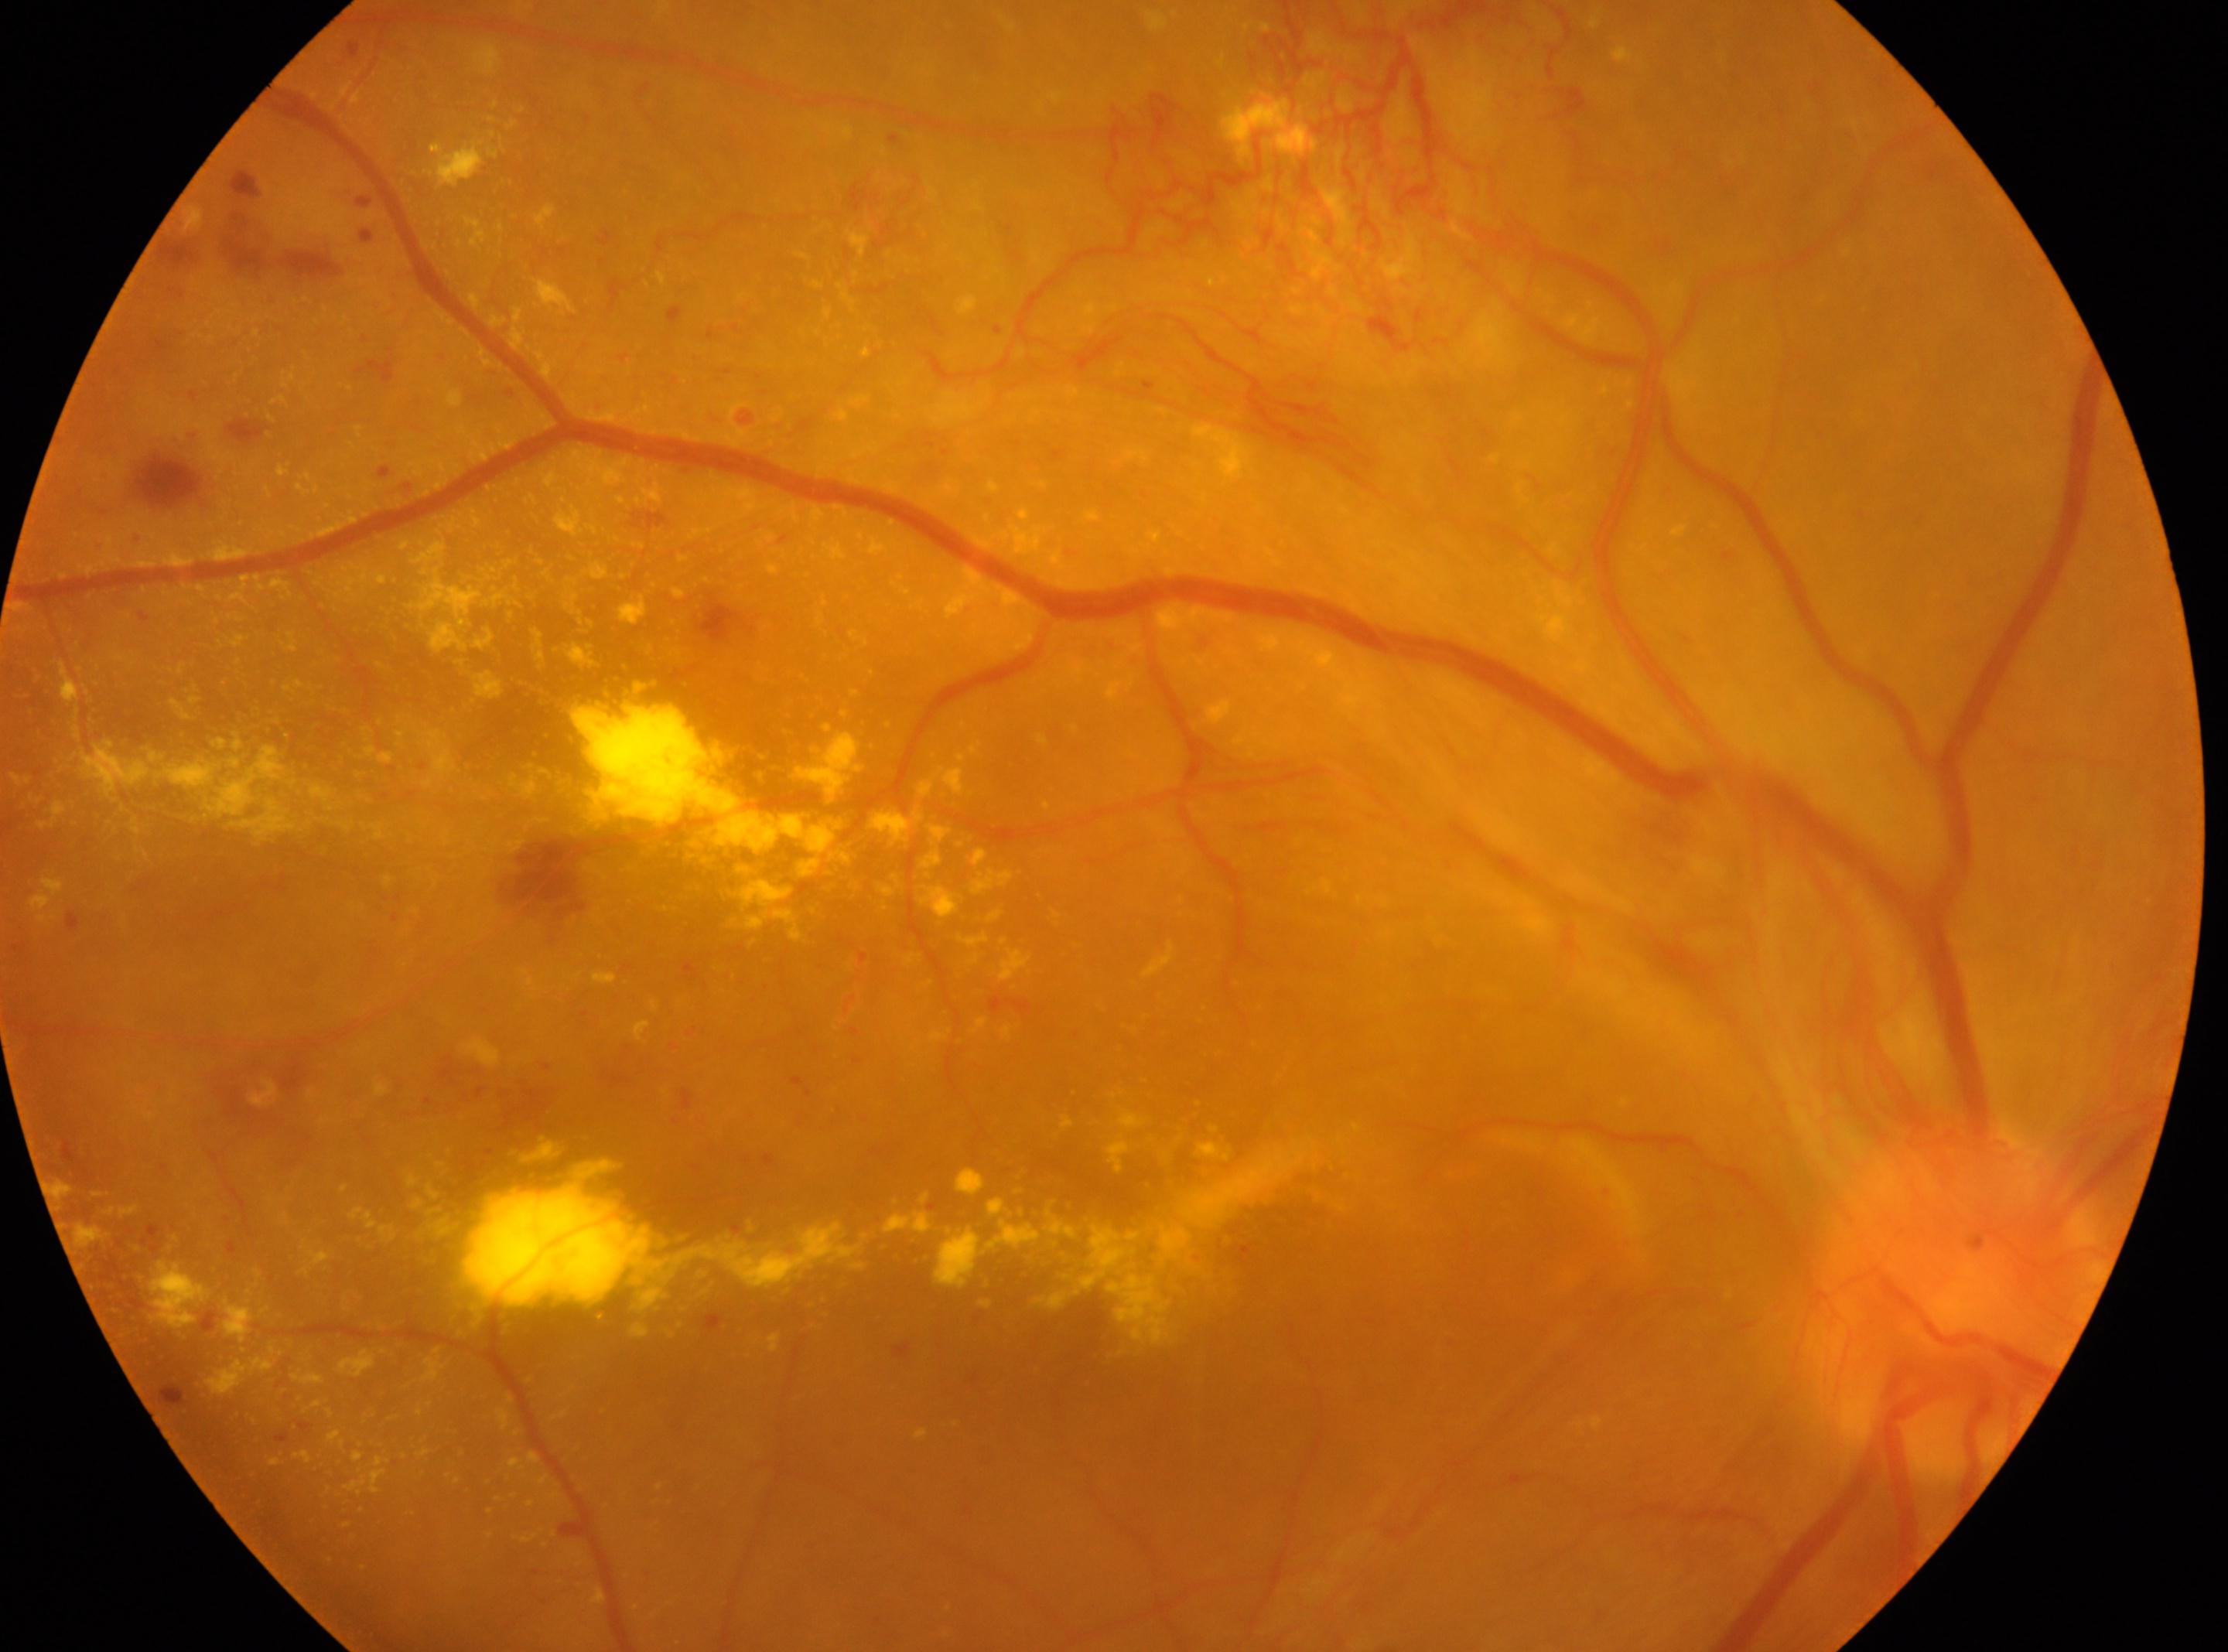 Fovea: x=1157, y=1217. The image shows the OD. Diabetic retinopathy grade is 4/4. The optic disc center is at x=1955, y=1299.